2352x1568; color fundus image; 45° field of view:
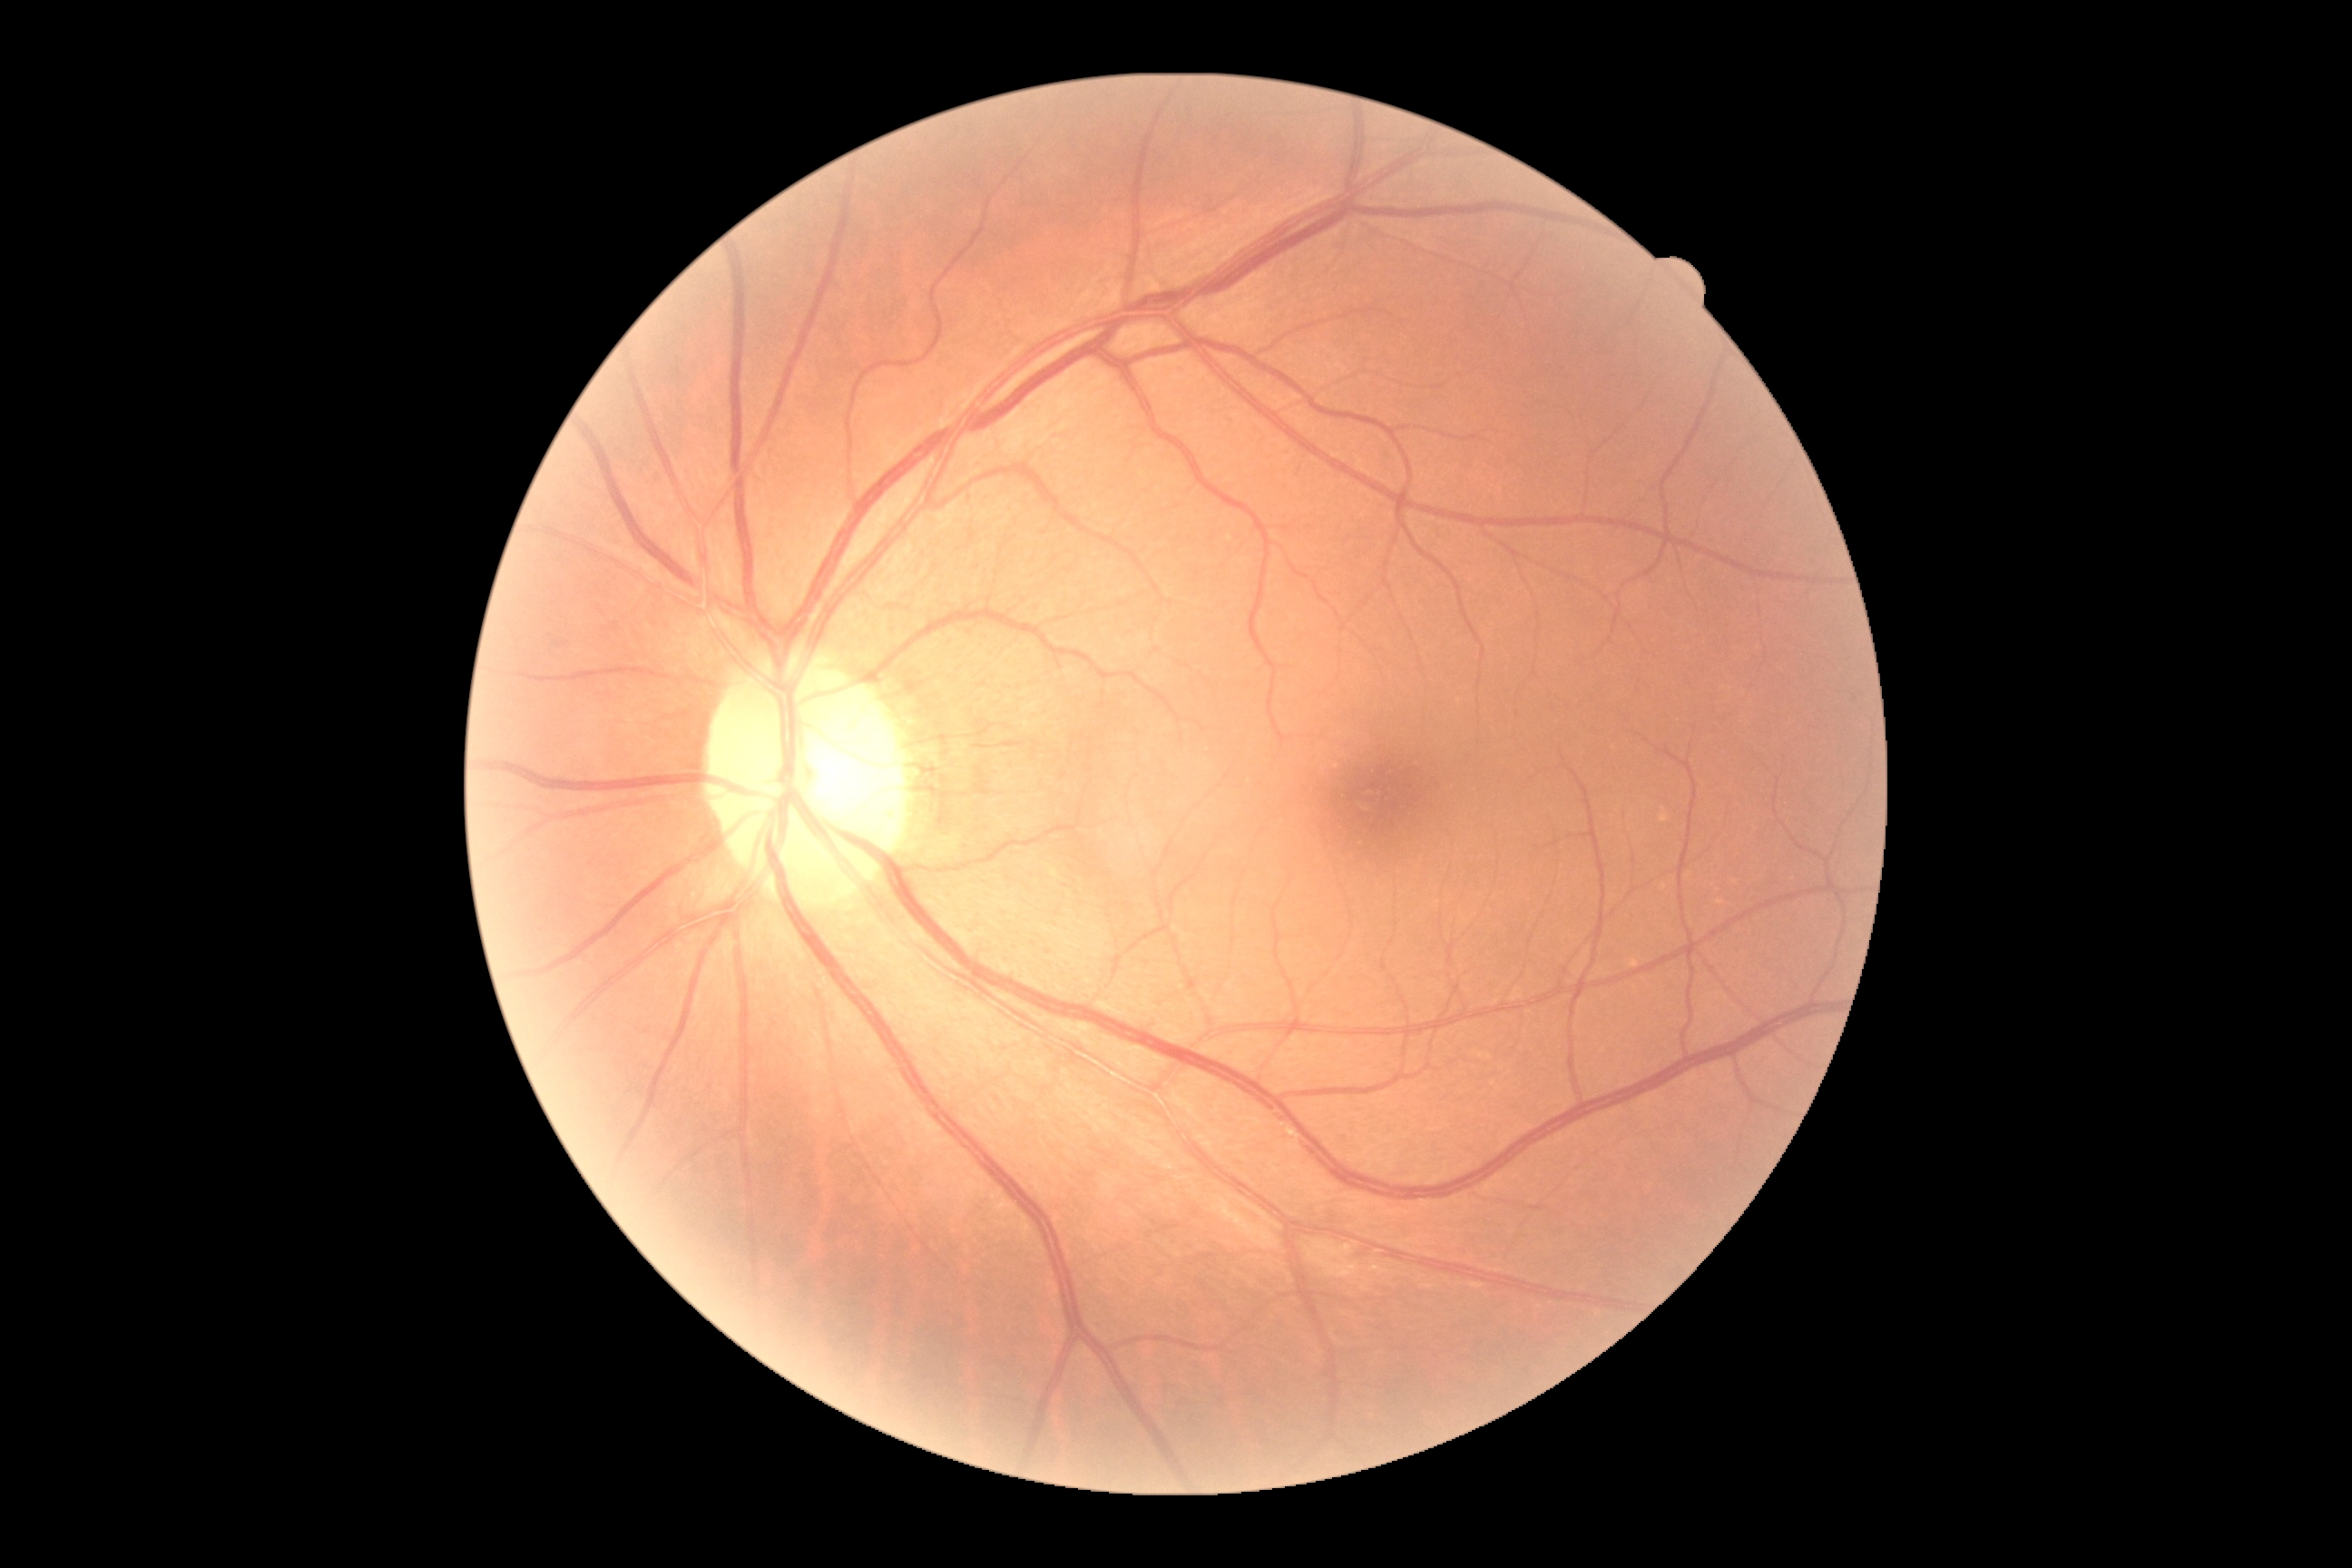 DR is 0/4.